848x848; color fundus photograph.
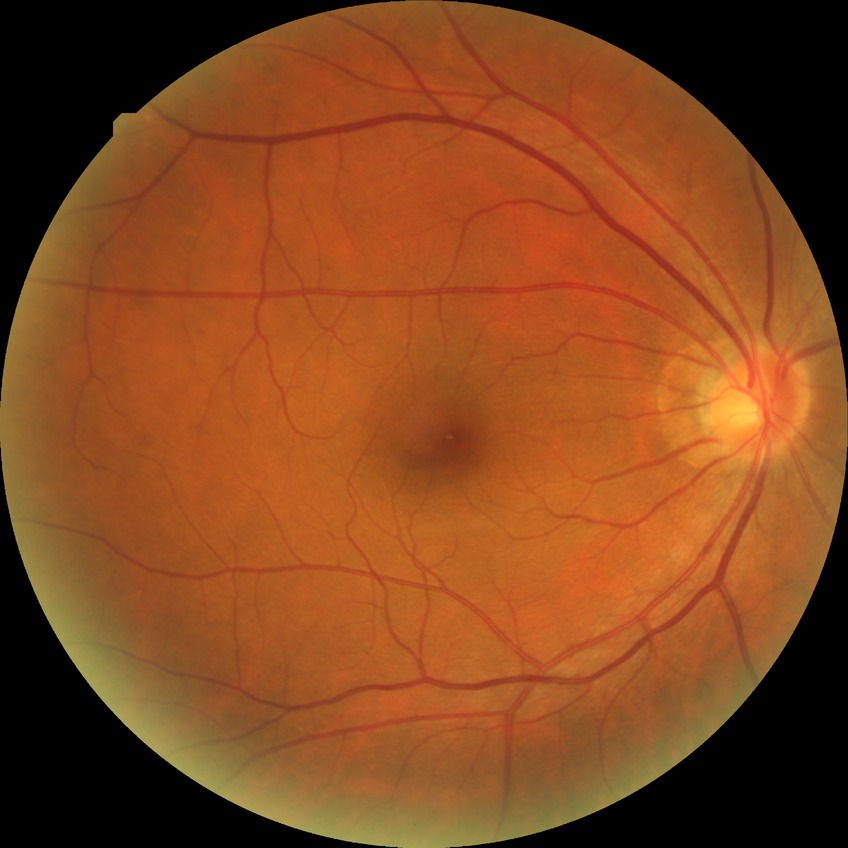
Diabetic retinopathy (DR): NDR (no diabetic retinopathy).